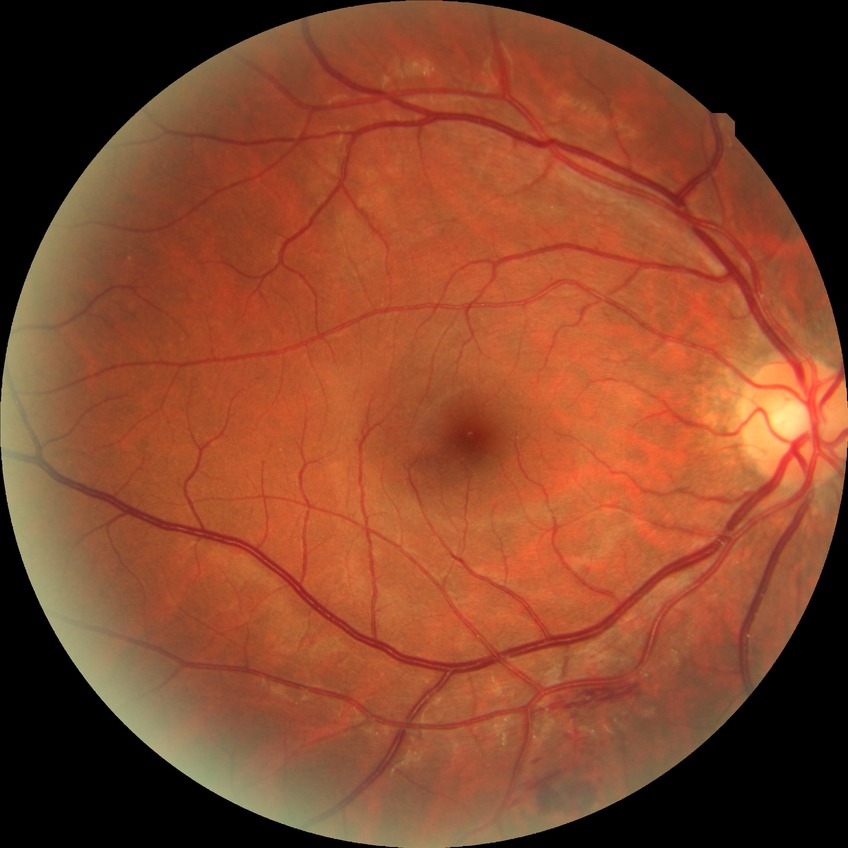 Diabetic retinopathy severity is no diabetic retinopathy.